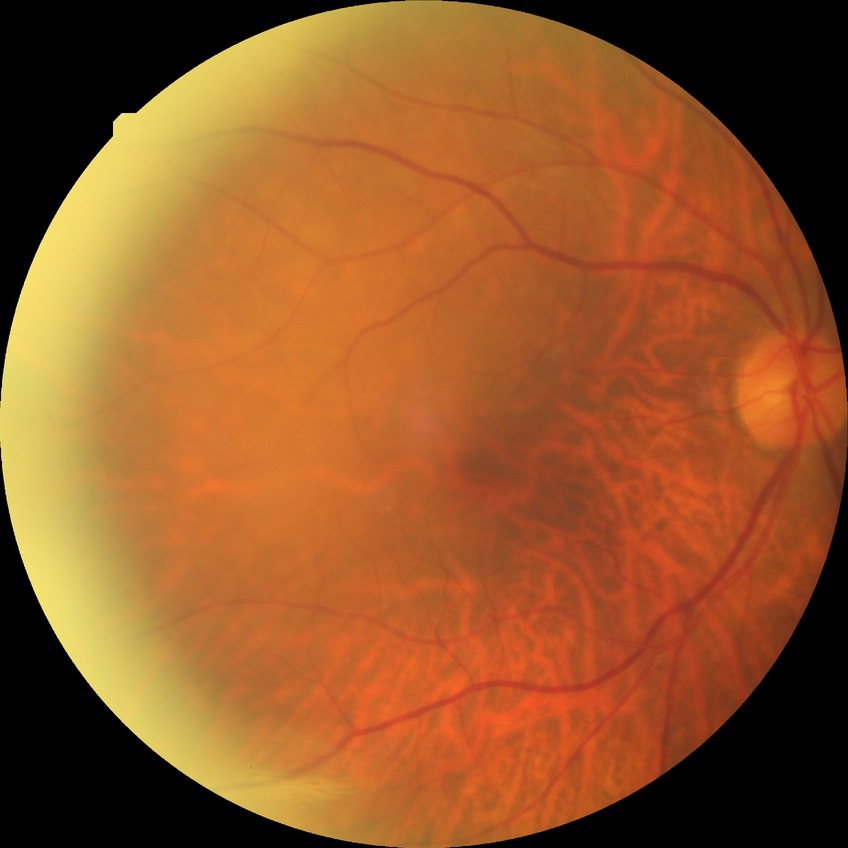
No apparent diabetic retinopathy. DR grade is NDR.